Captured with the Clarity RetCam 3 (130° field of view). Wide-field fundus photograph from neonatal ROP screening. 640x480 — 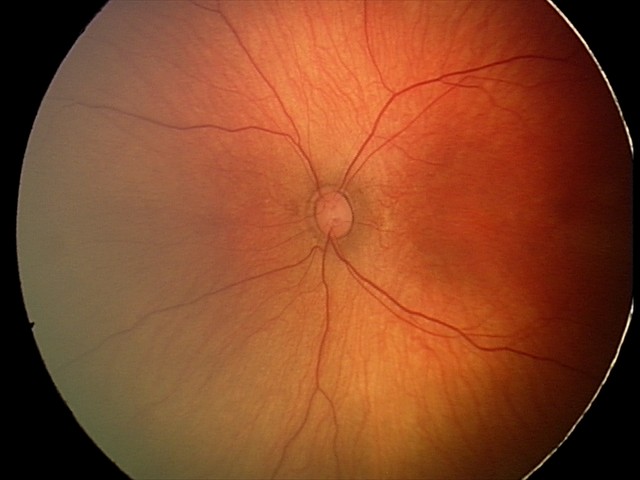
Screening examination diagnosed as physiological.